45-degree field of view.
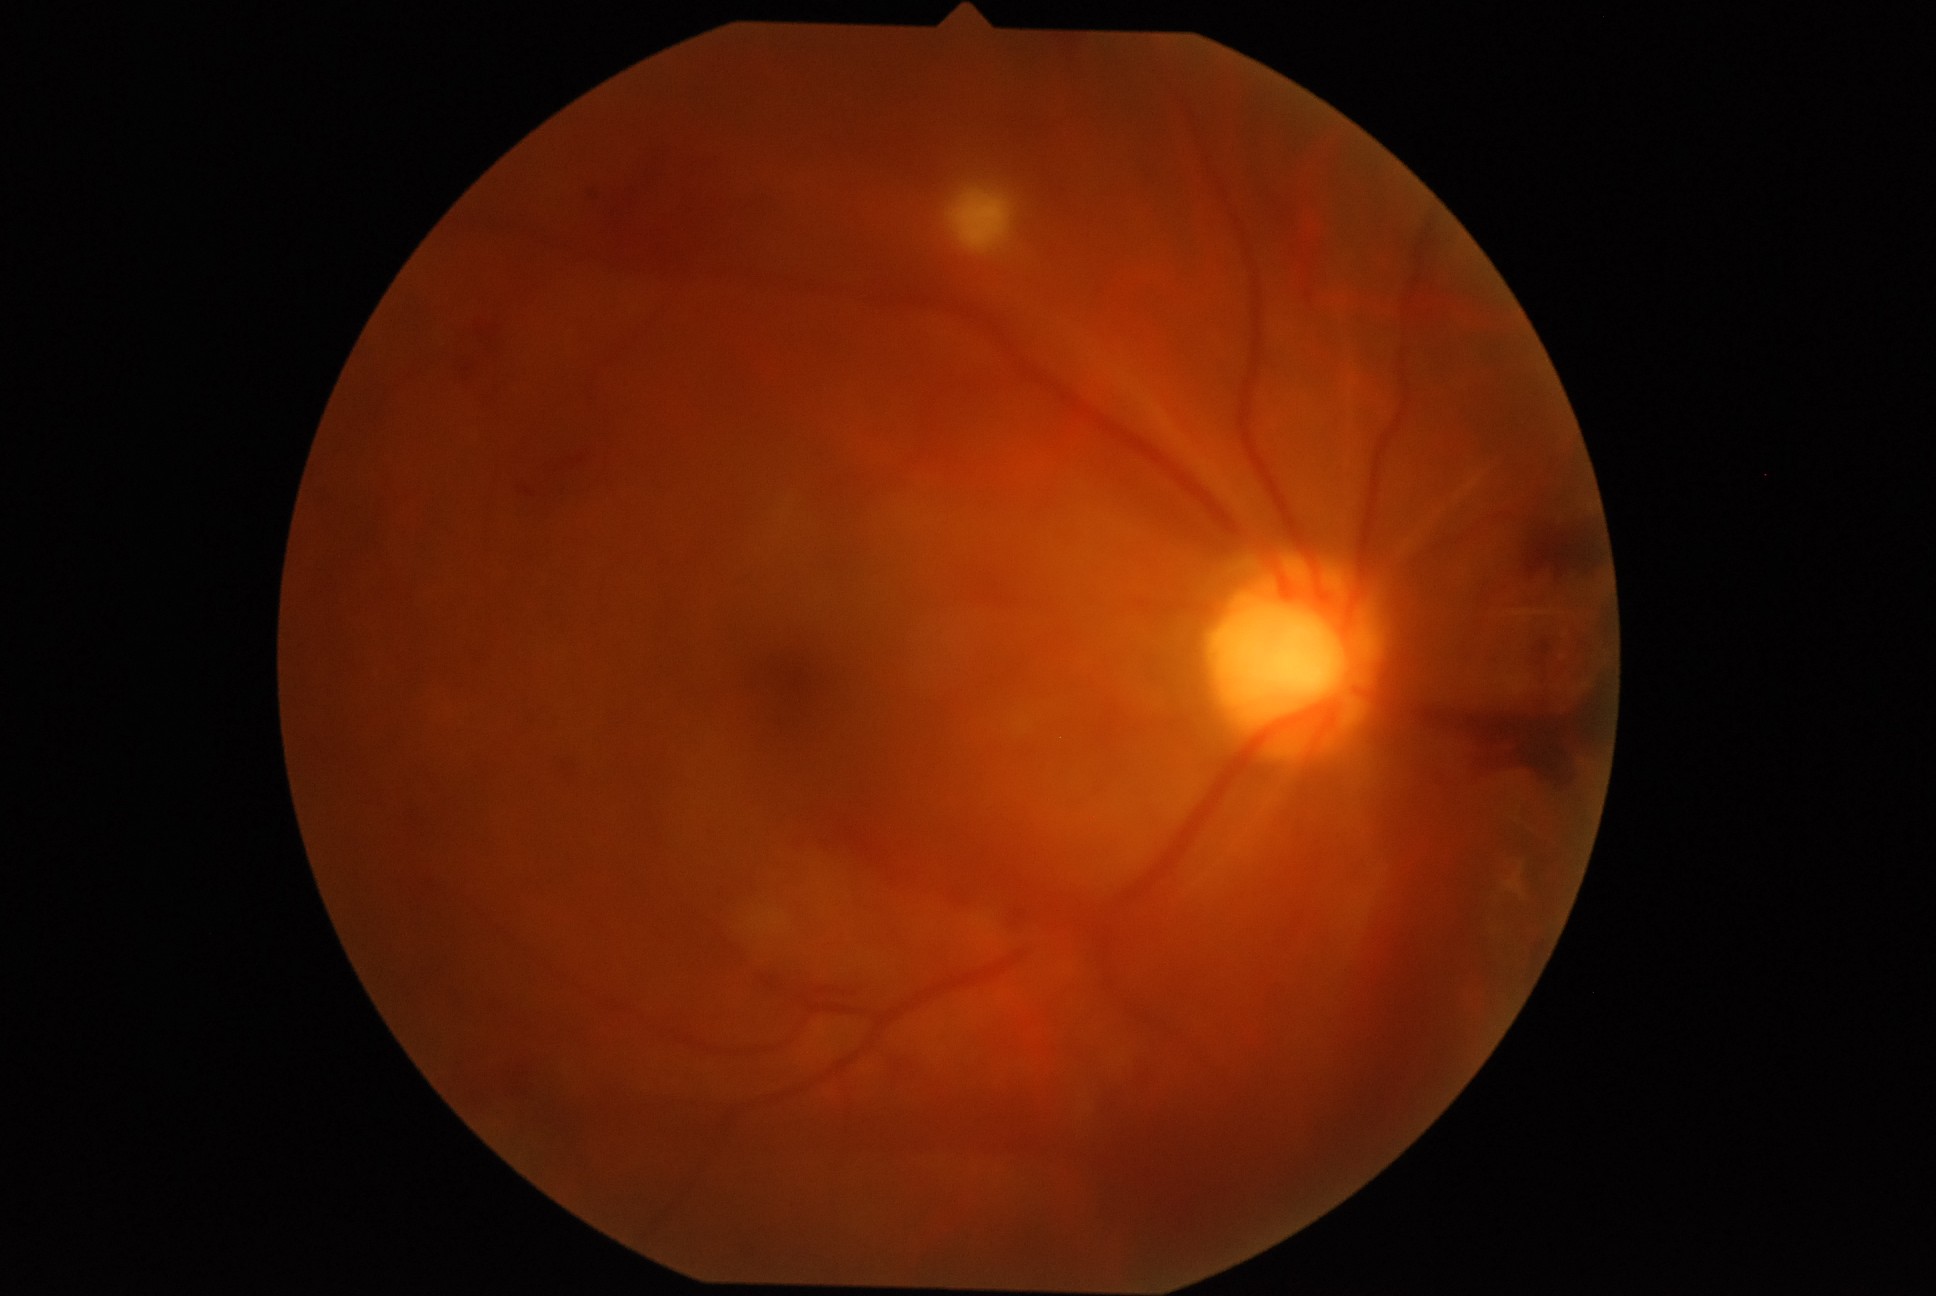 Diabetic retinopathy (DR): proliferative diabetic retinopathy (grade 4).